Optic disc photograph.
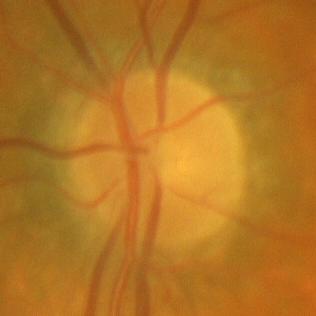
Findings consistent with no glaucoma.